50° FOV: 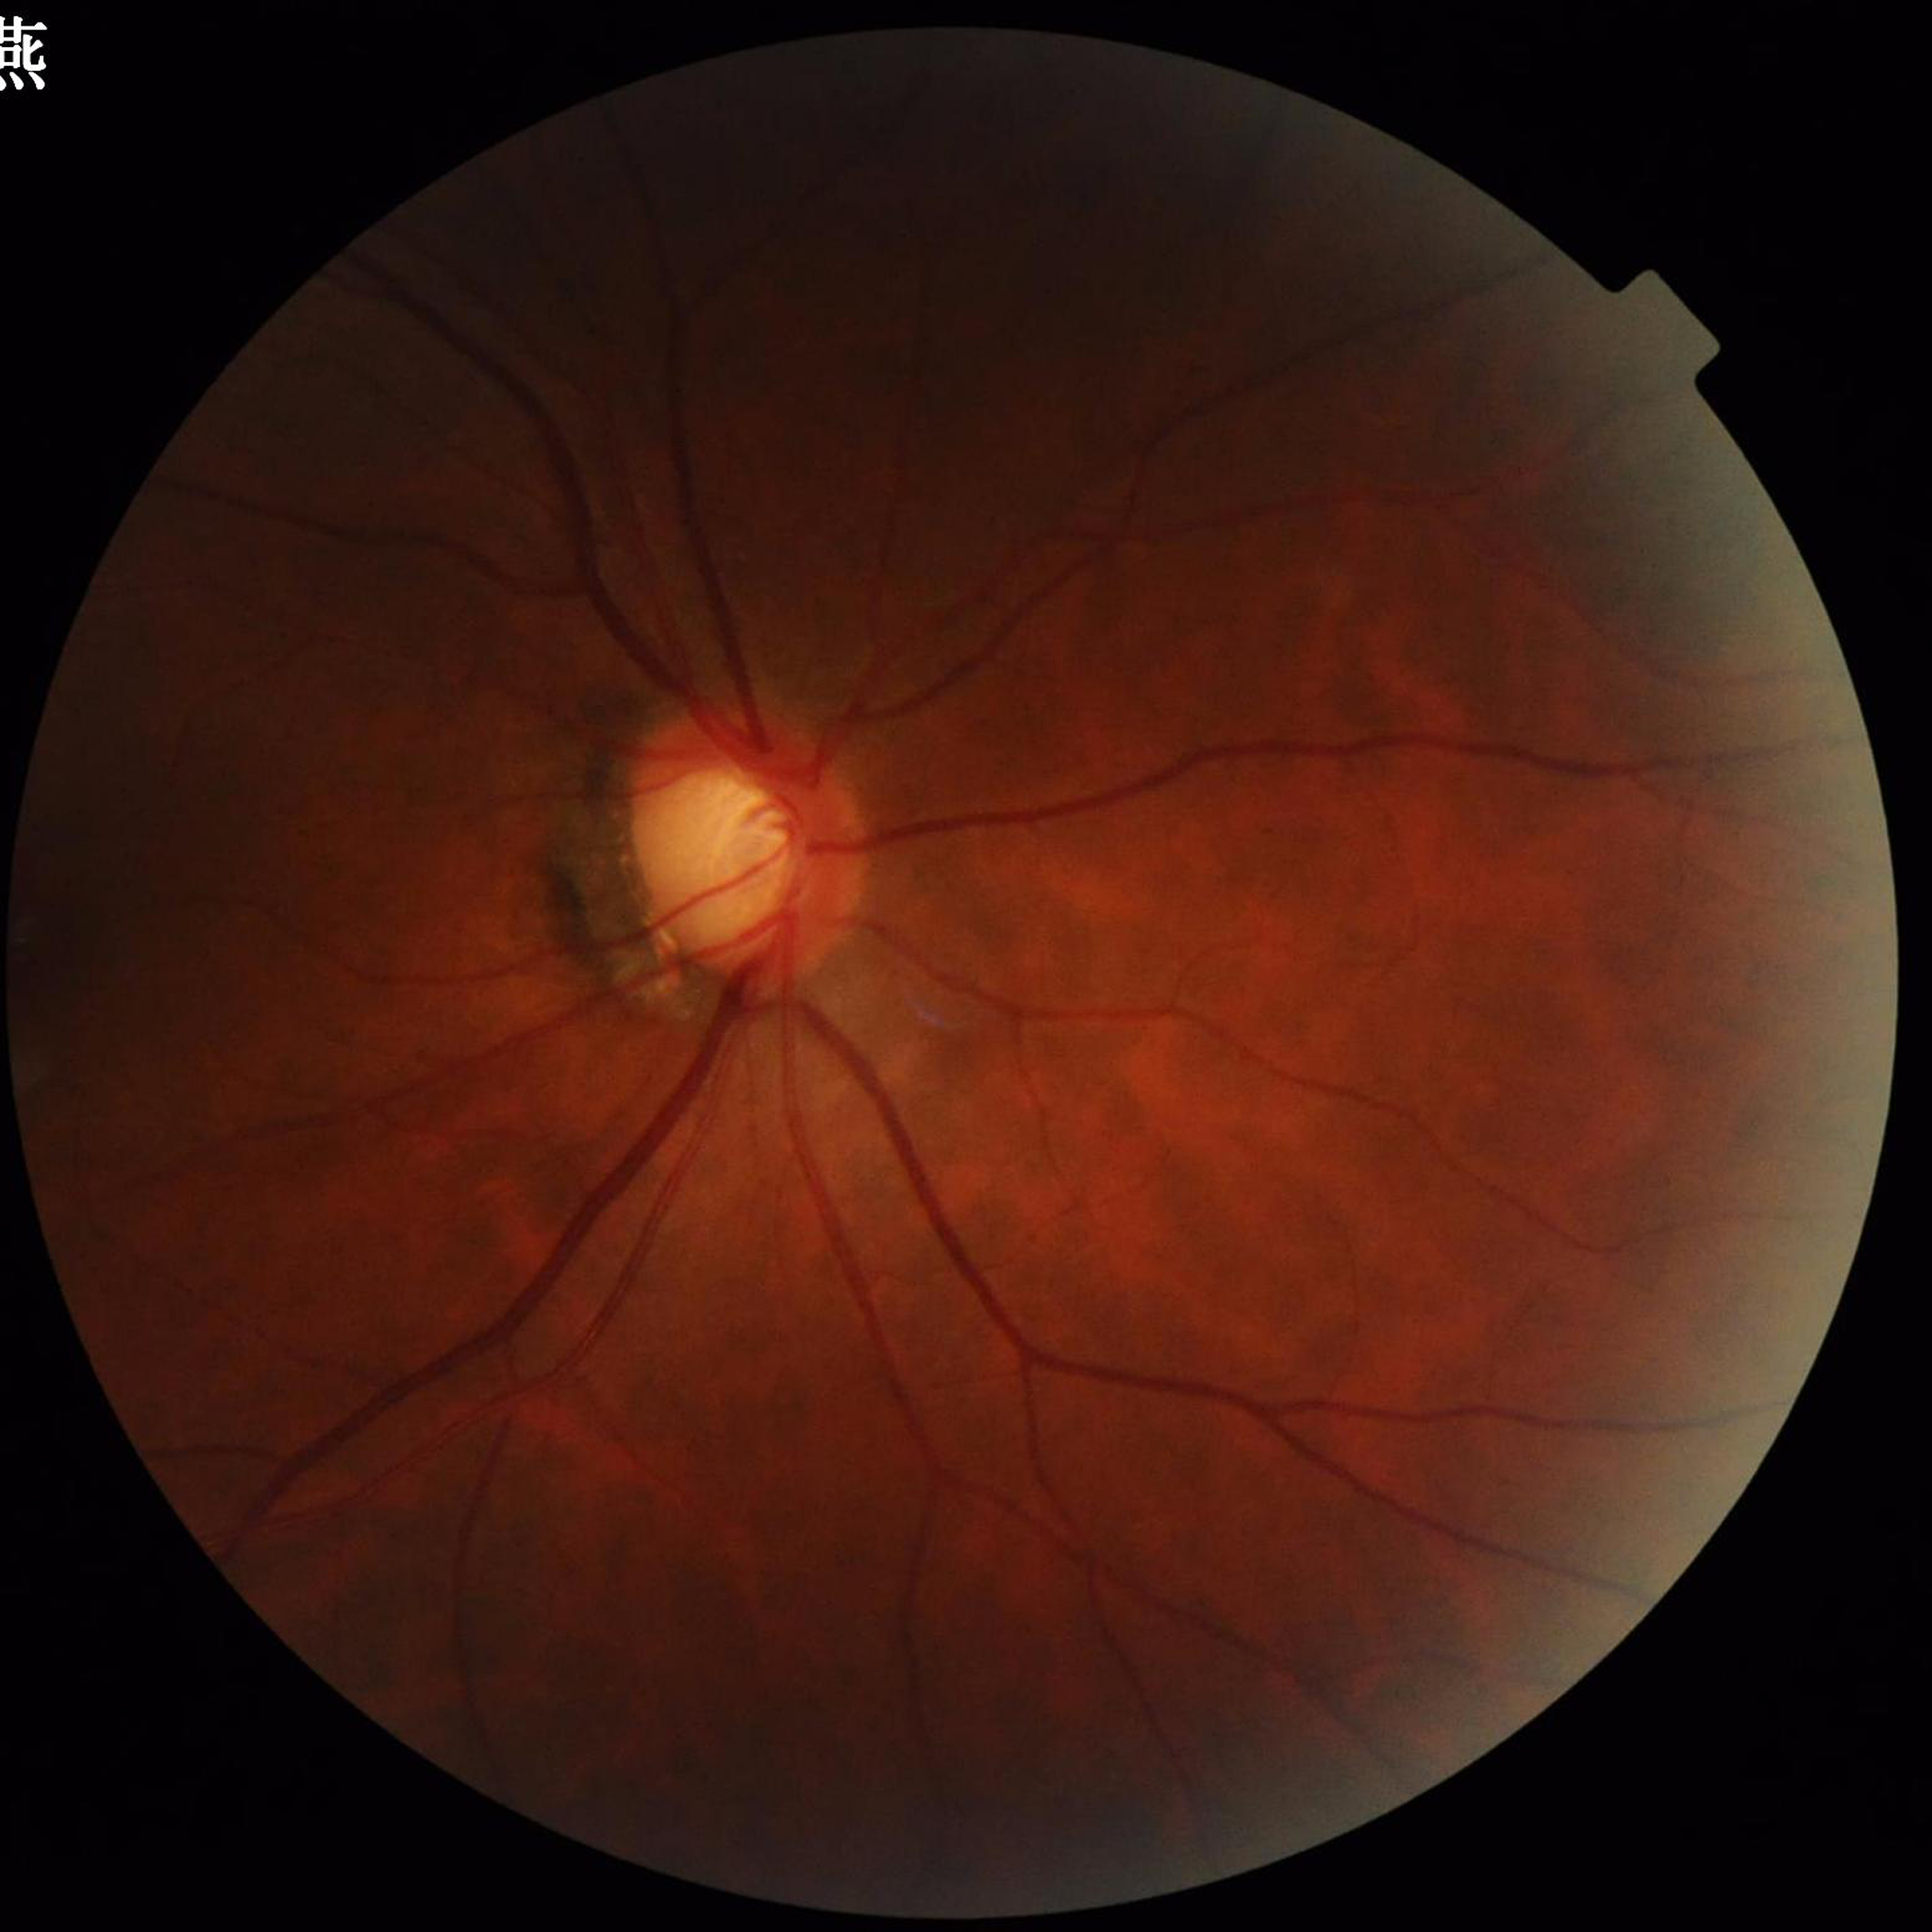

The patient was diagnosed with glaucoma. Quality assessment: adequate.